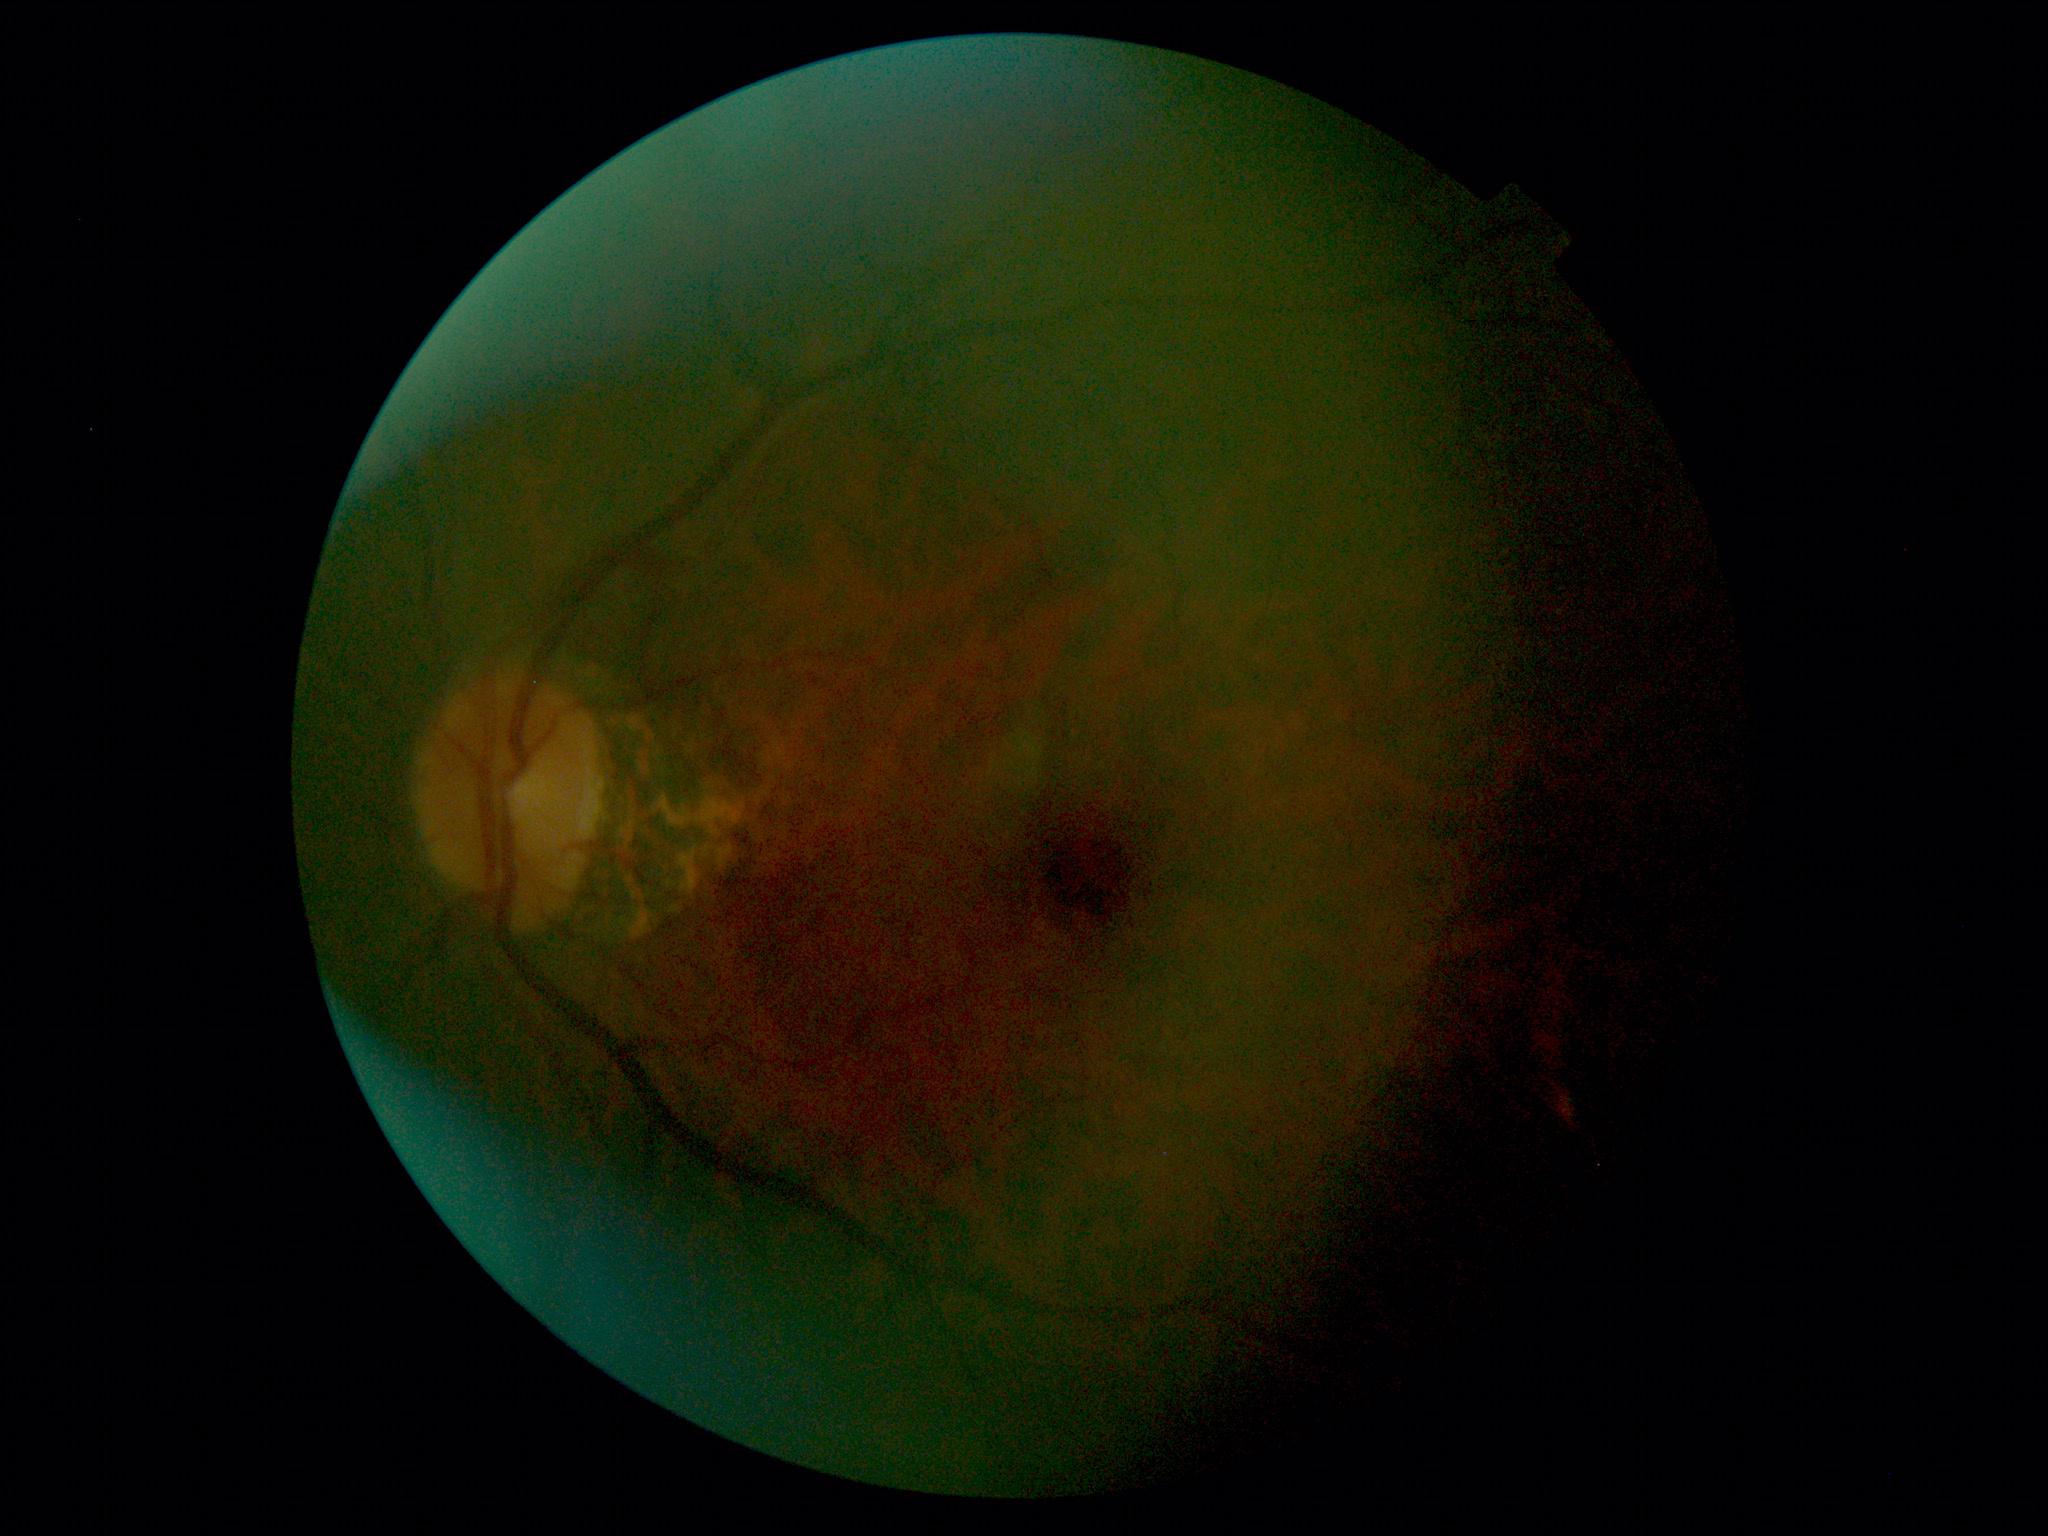
DR grade: 0.